Image size 1920x1088
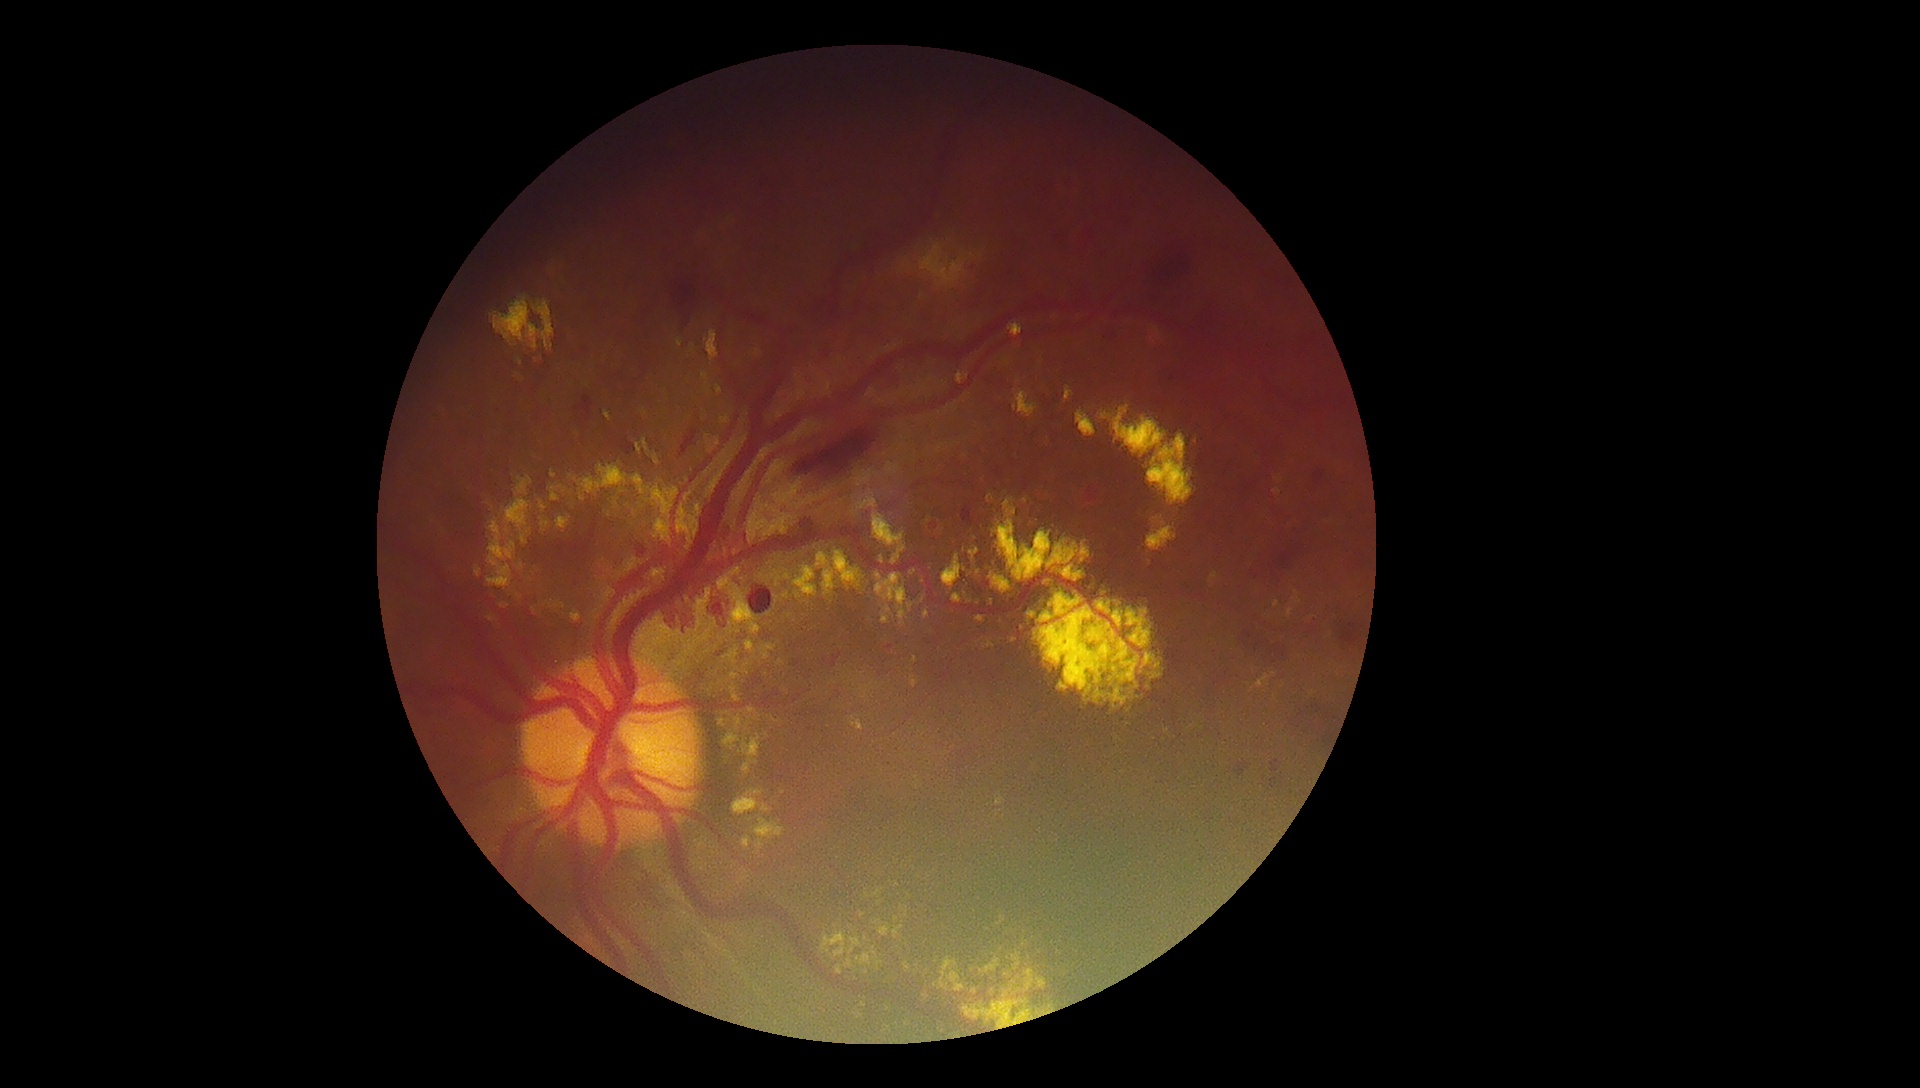

DR severity: grade 4 (PDR) — neovascularization and/or vitreous/pre-retinal hemorrhage
Selected lesions:
EXs (continued): <bbox>997, 916, 1006, 926</bbox>; <bbox>653, 520, 673, 544</bbox>; <bbox>505, 498, 531, 533</bbox>; <bbox>873, 512, 906, 565</bbox>; <bbox>550, 485, 567, 502</bbox>; <bbox>910, 681, 919, 689</bbox>; <bbox>879, 927, 891, 937</bbox>; <bbox>856, 953, 872, 967</bbox>; <bbox>1102, 404, 1196, 506</bbox>; <bbox>1209, 572, 1219, 588</bbox>; <bbox>1275, 478, 1284, 484</bbox>; <bbox>515, 373, 523, 380</bbox>
Smaller EXs around point(1331, 635); point(889, 1009); point(534, 610); point(972, 255); point(507, 531); point(770, 564); point(529, 531)